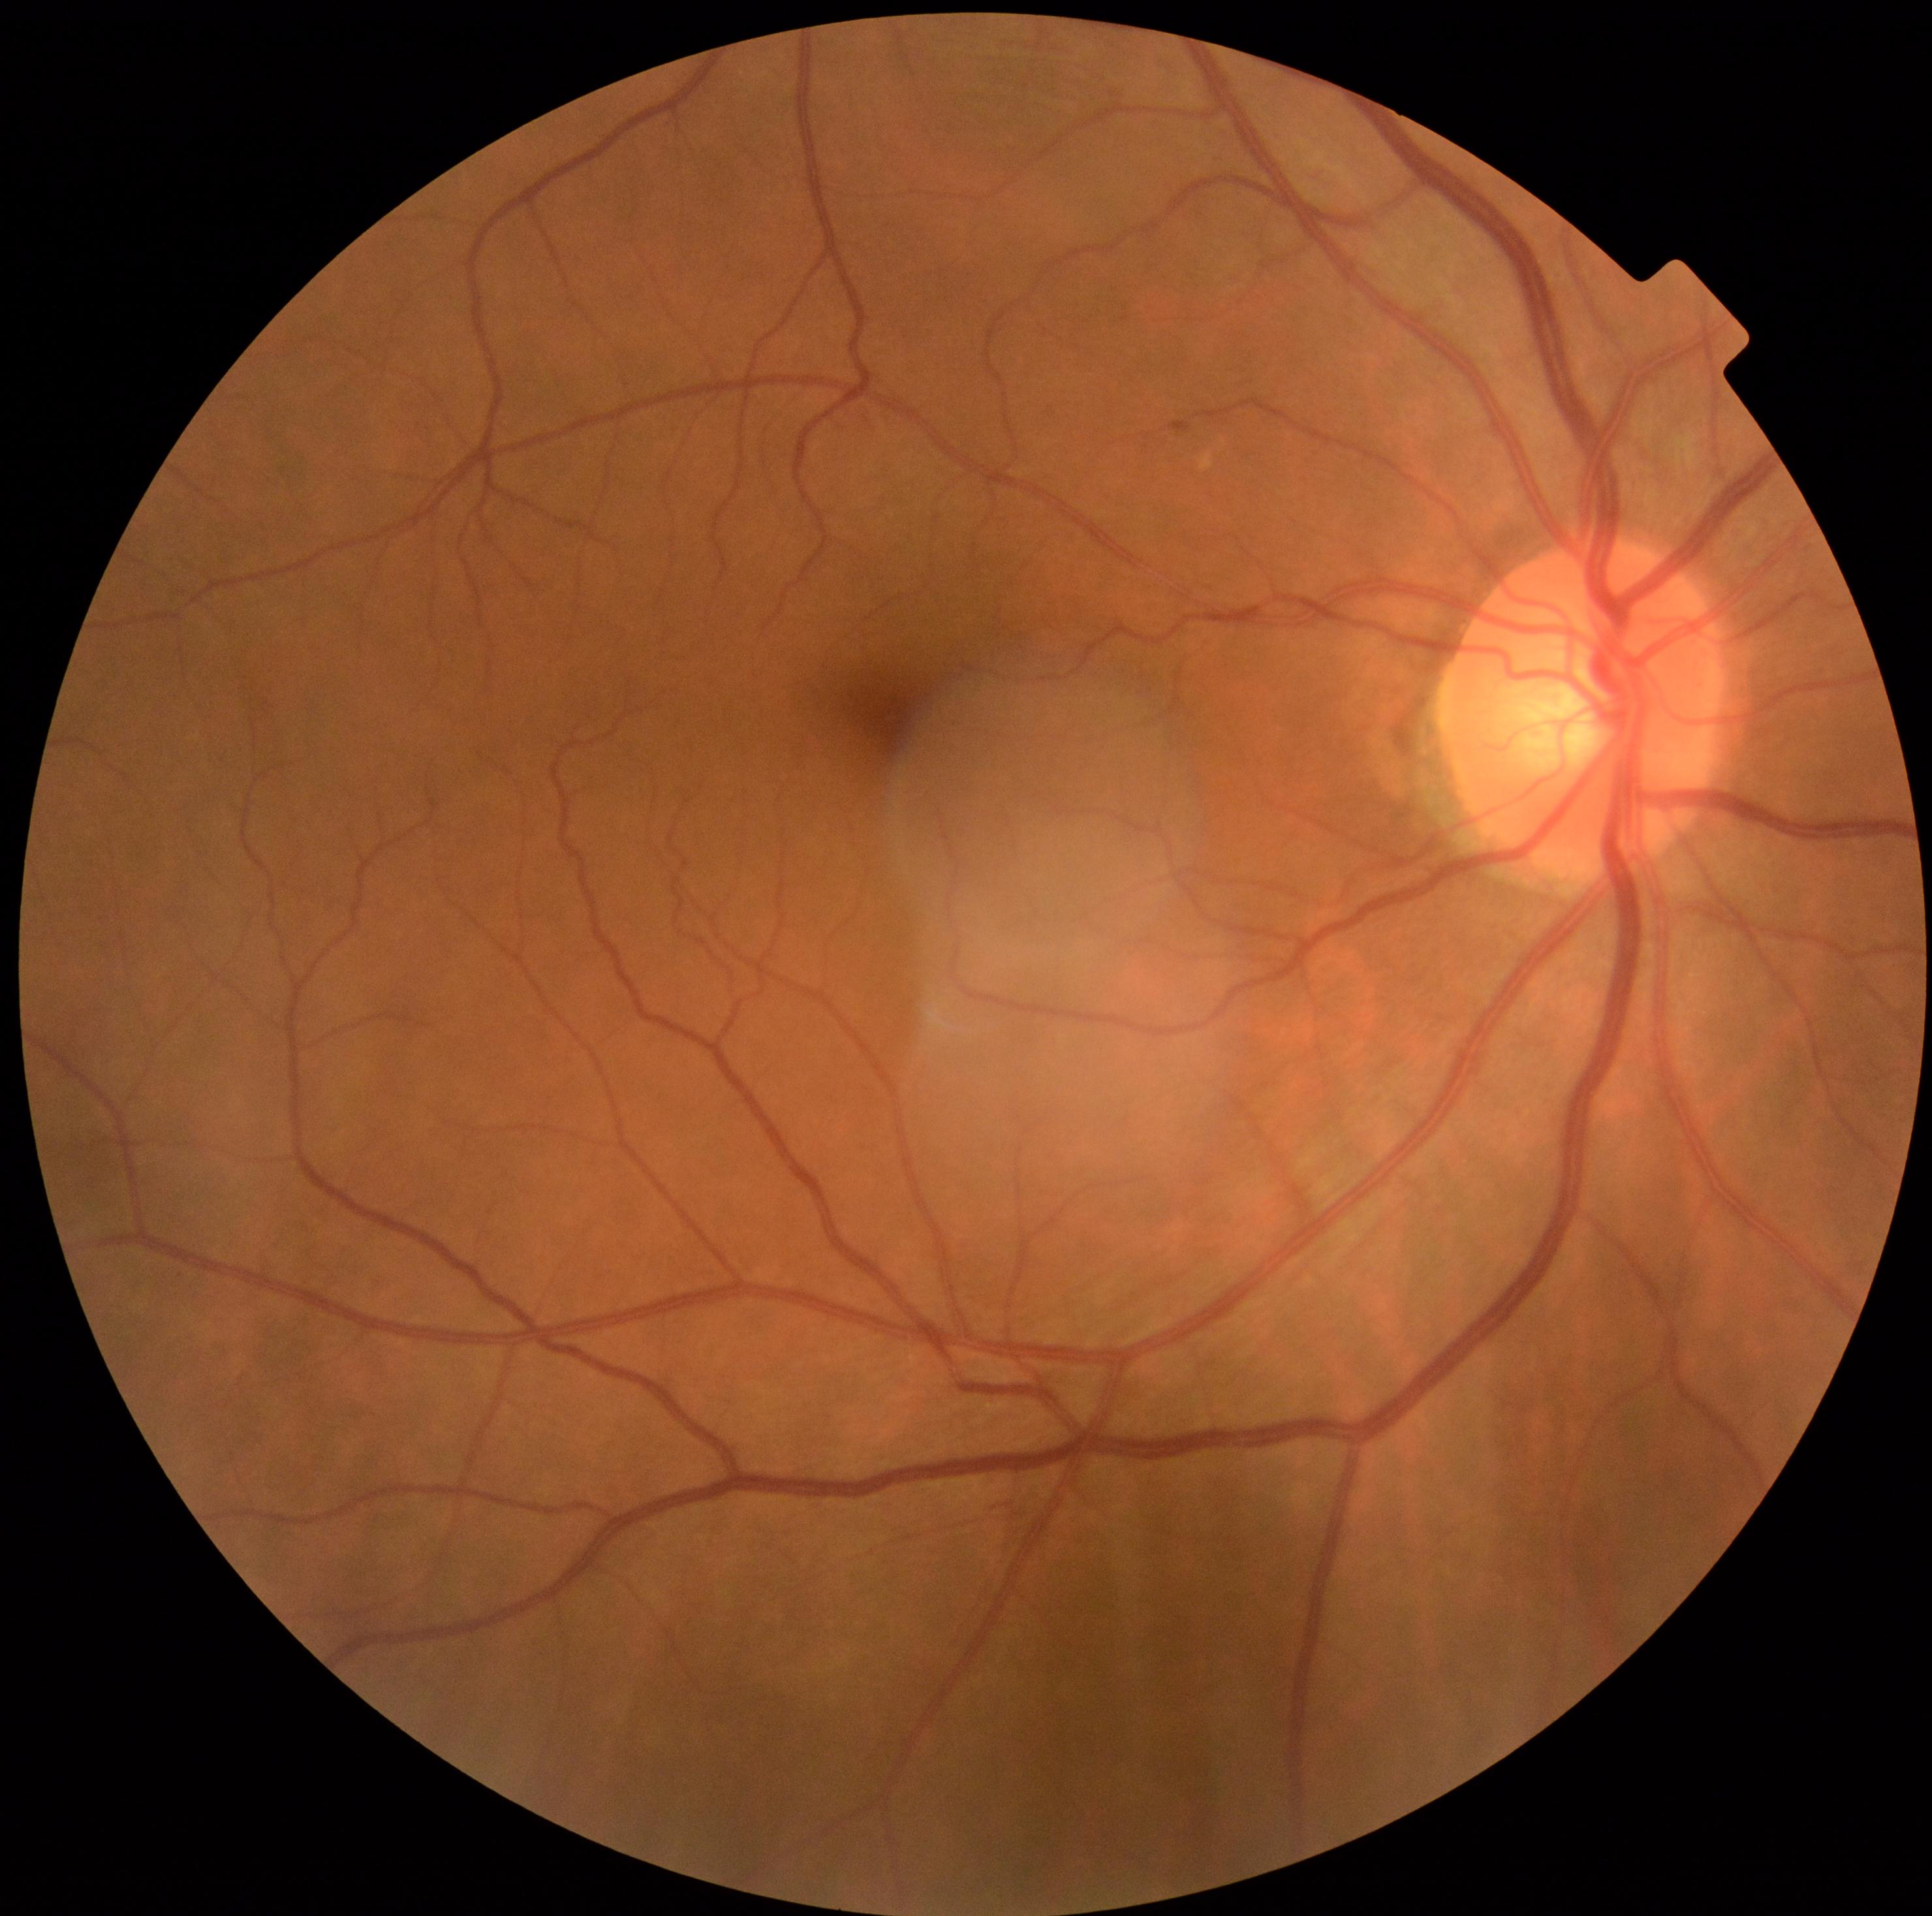
{"dr_grade": "grade 0 (no apparent retinopathy)"}